2212 x 1659 pixels:
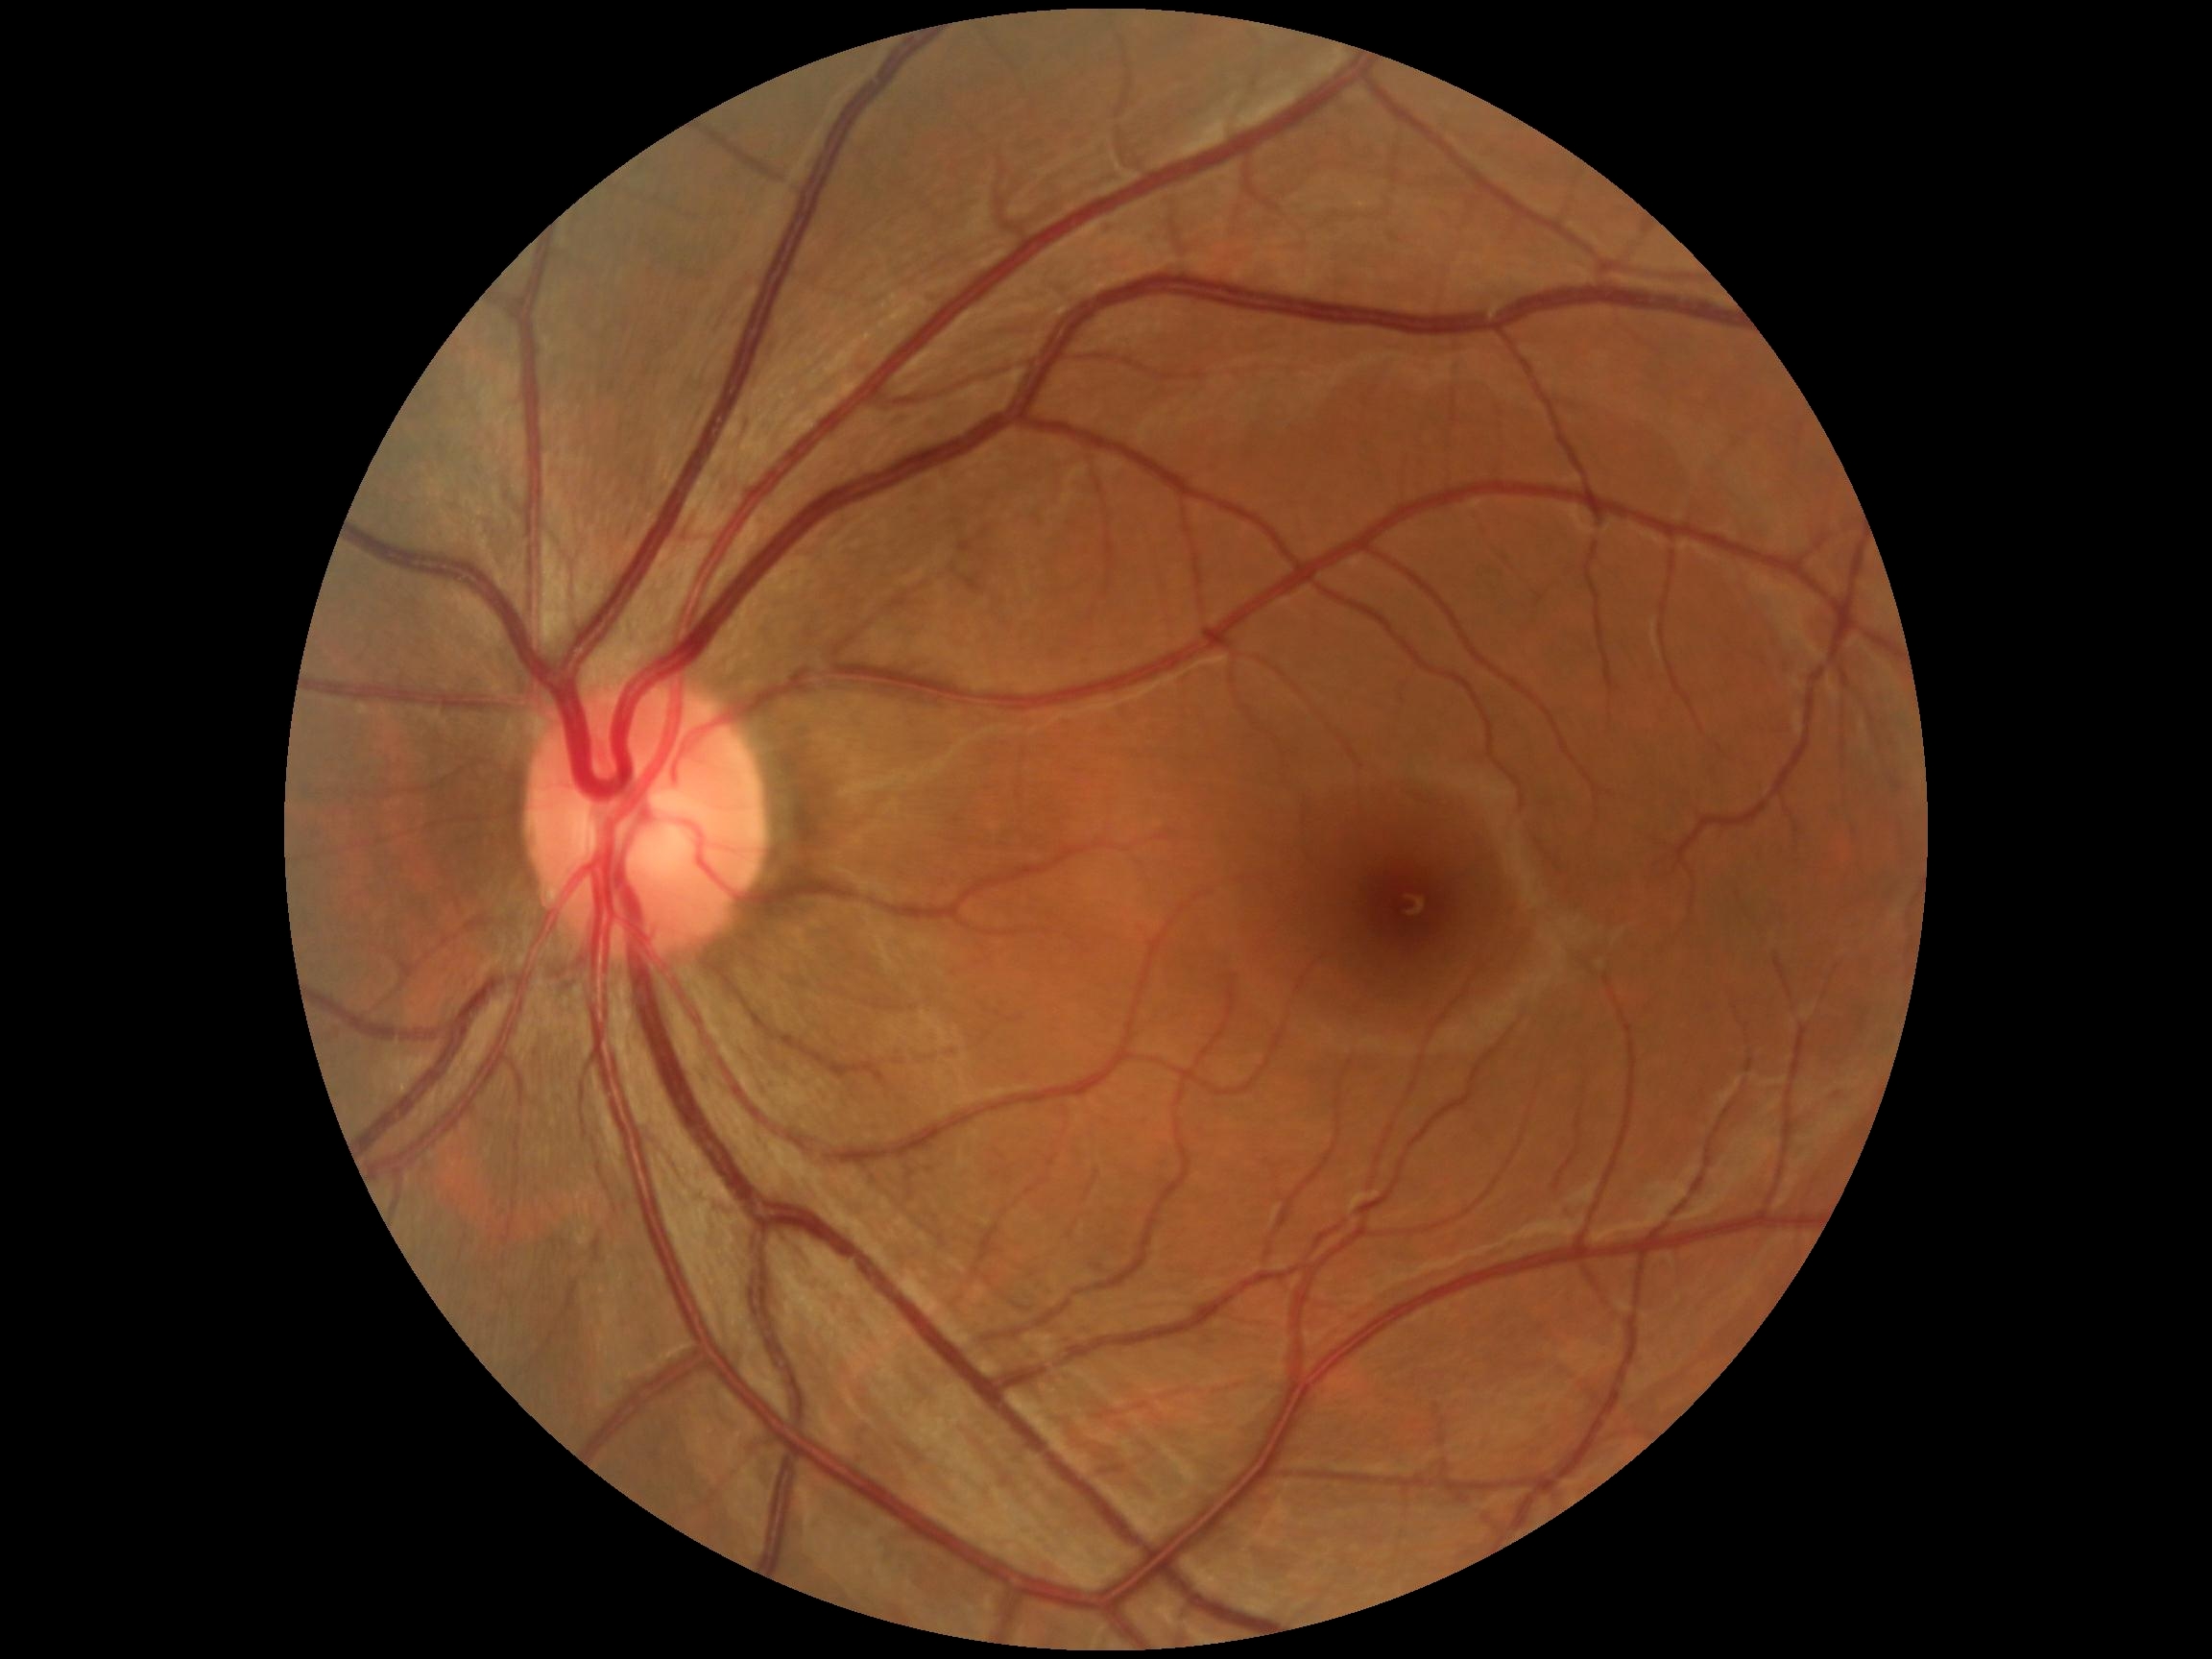
Diabetic retinopathy (DR) is 0.